Camera: NIDEK AFC-230
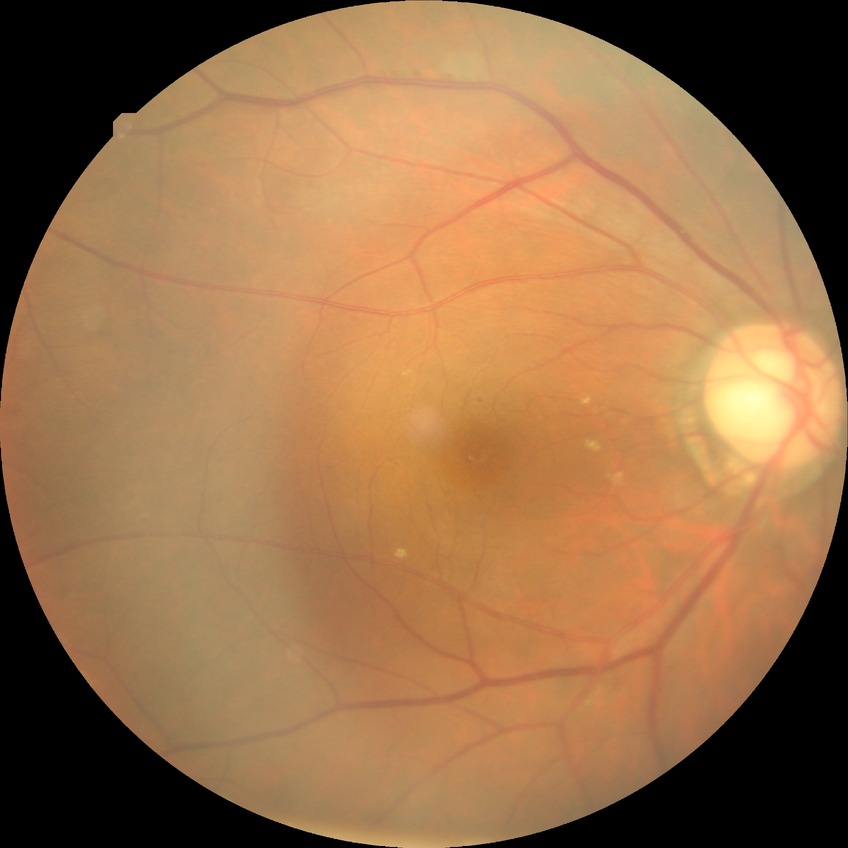
Retinopathy stage: simple diabetic retinopathy.